NIDEK AFC-230 fundus camera · FOV: 45 degrees · fundus photo: 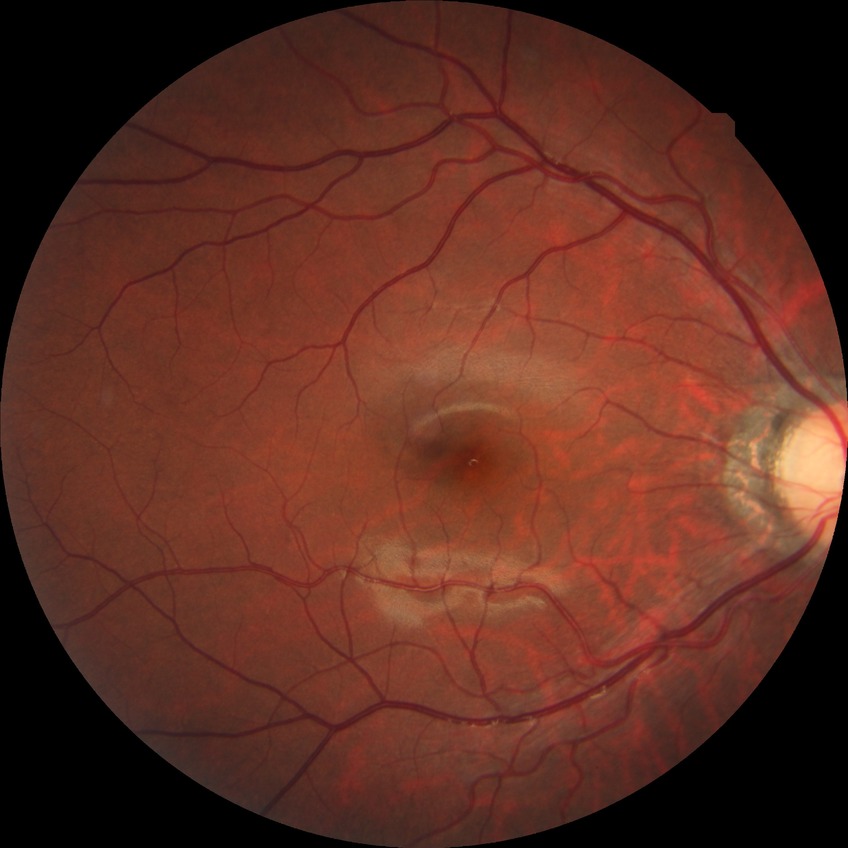 Diabetic retinopathy (DR): NDR (no diabetic retinopathy).